Nonmydriatic · 848x848 · color fundus photograph · modified Davis classification.
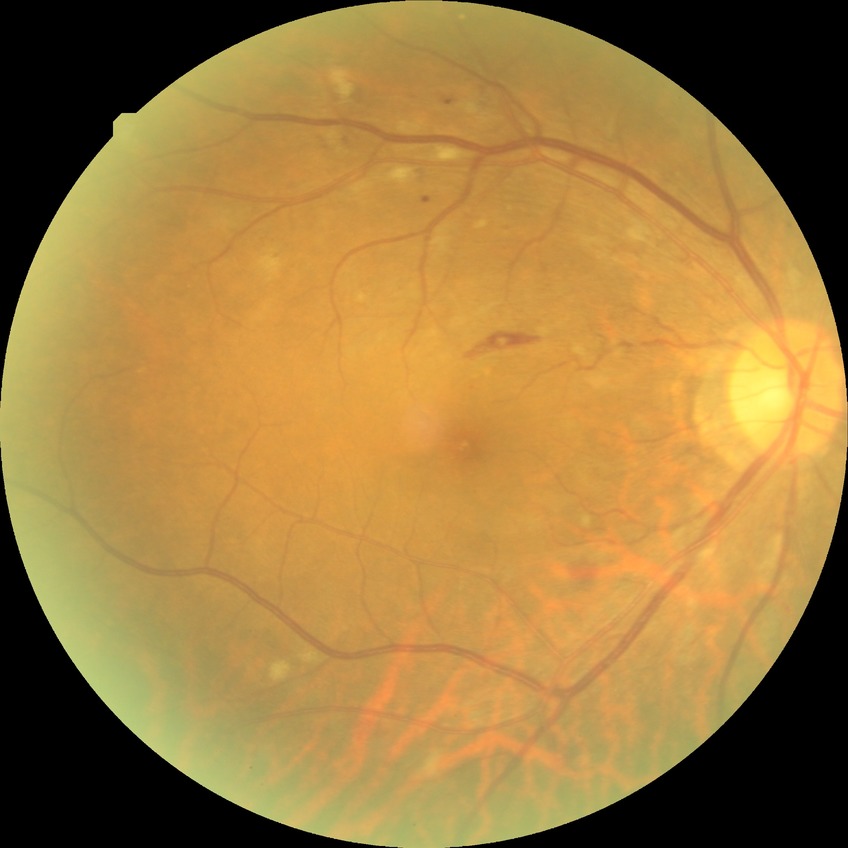

Diabetic retinopathy (DR): pre-proliferative diabetic retinopathy (PPDR). Disease class: non-proliferative diabetic retinopathy.